Posterior pole color fundus photograph. 45-degree field of view
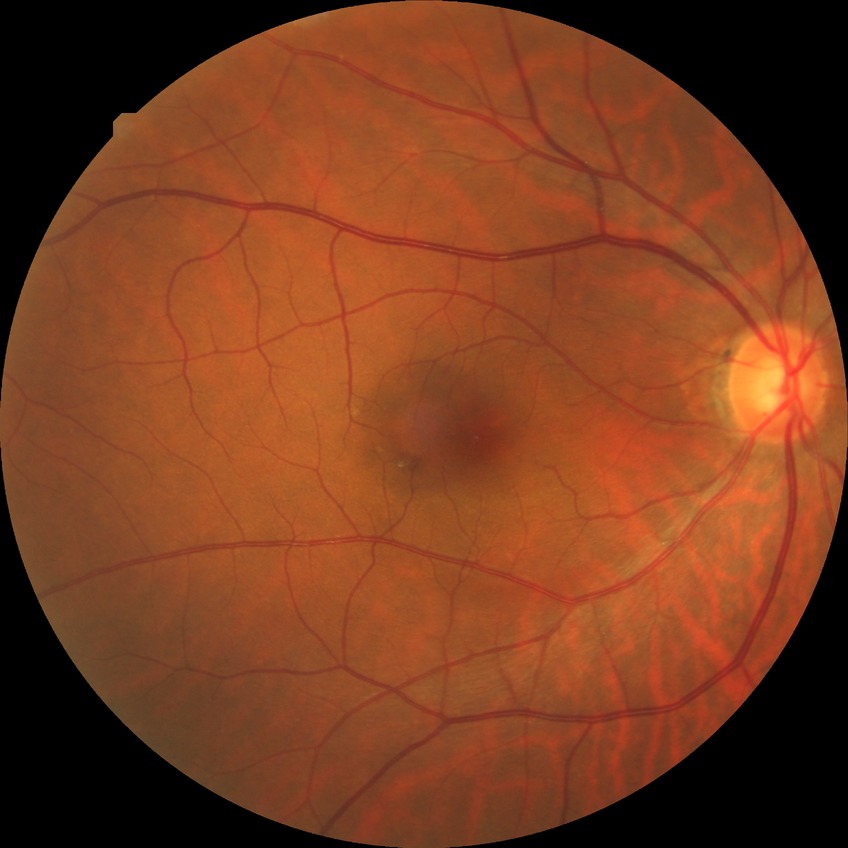 Diabetic retinopathy (DR): NDR (no diabetic retinopathy).